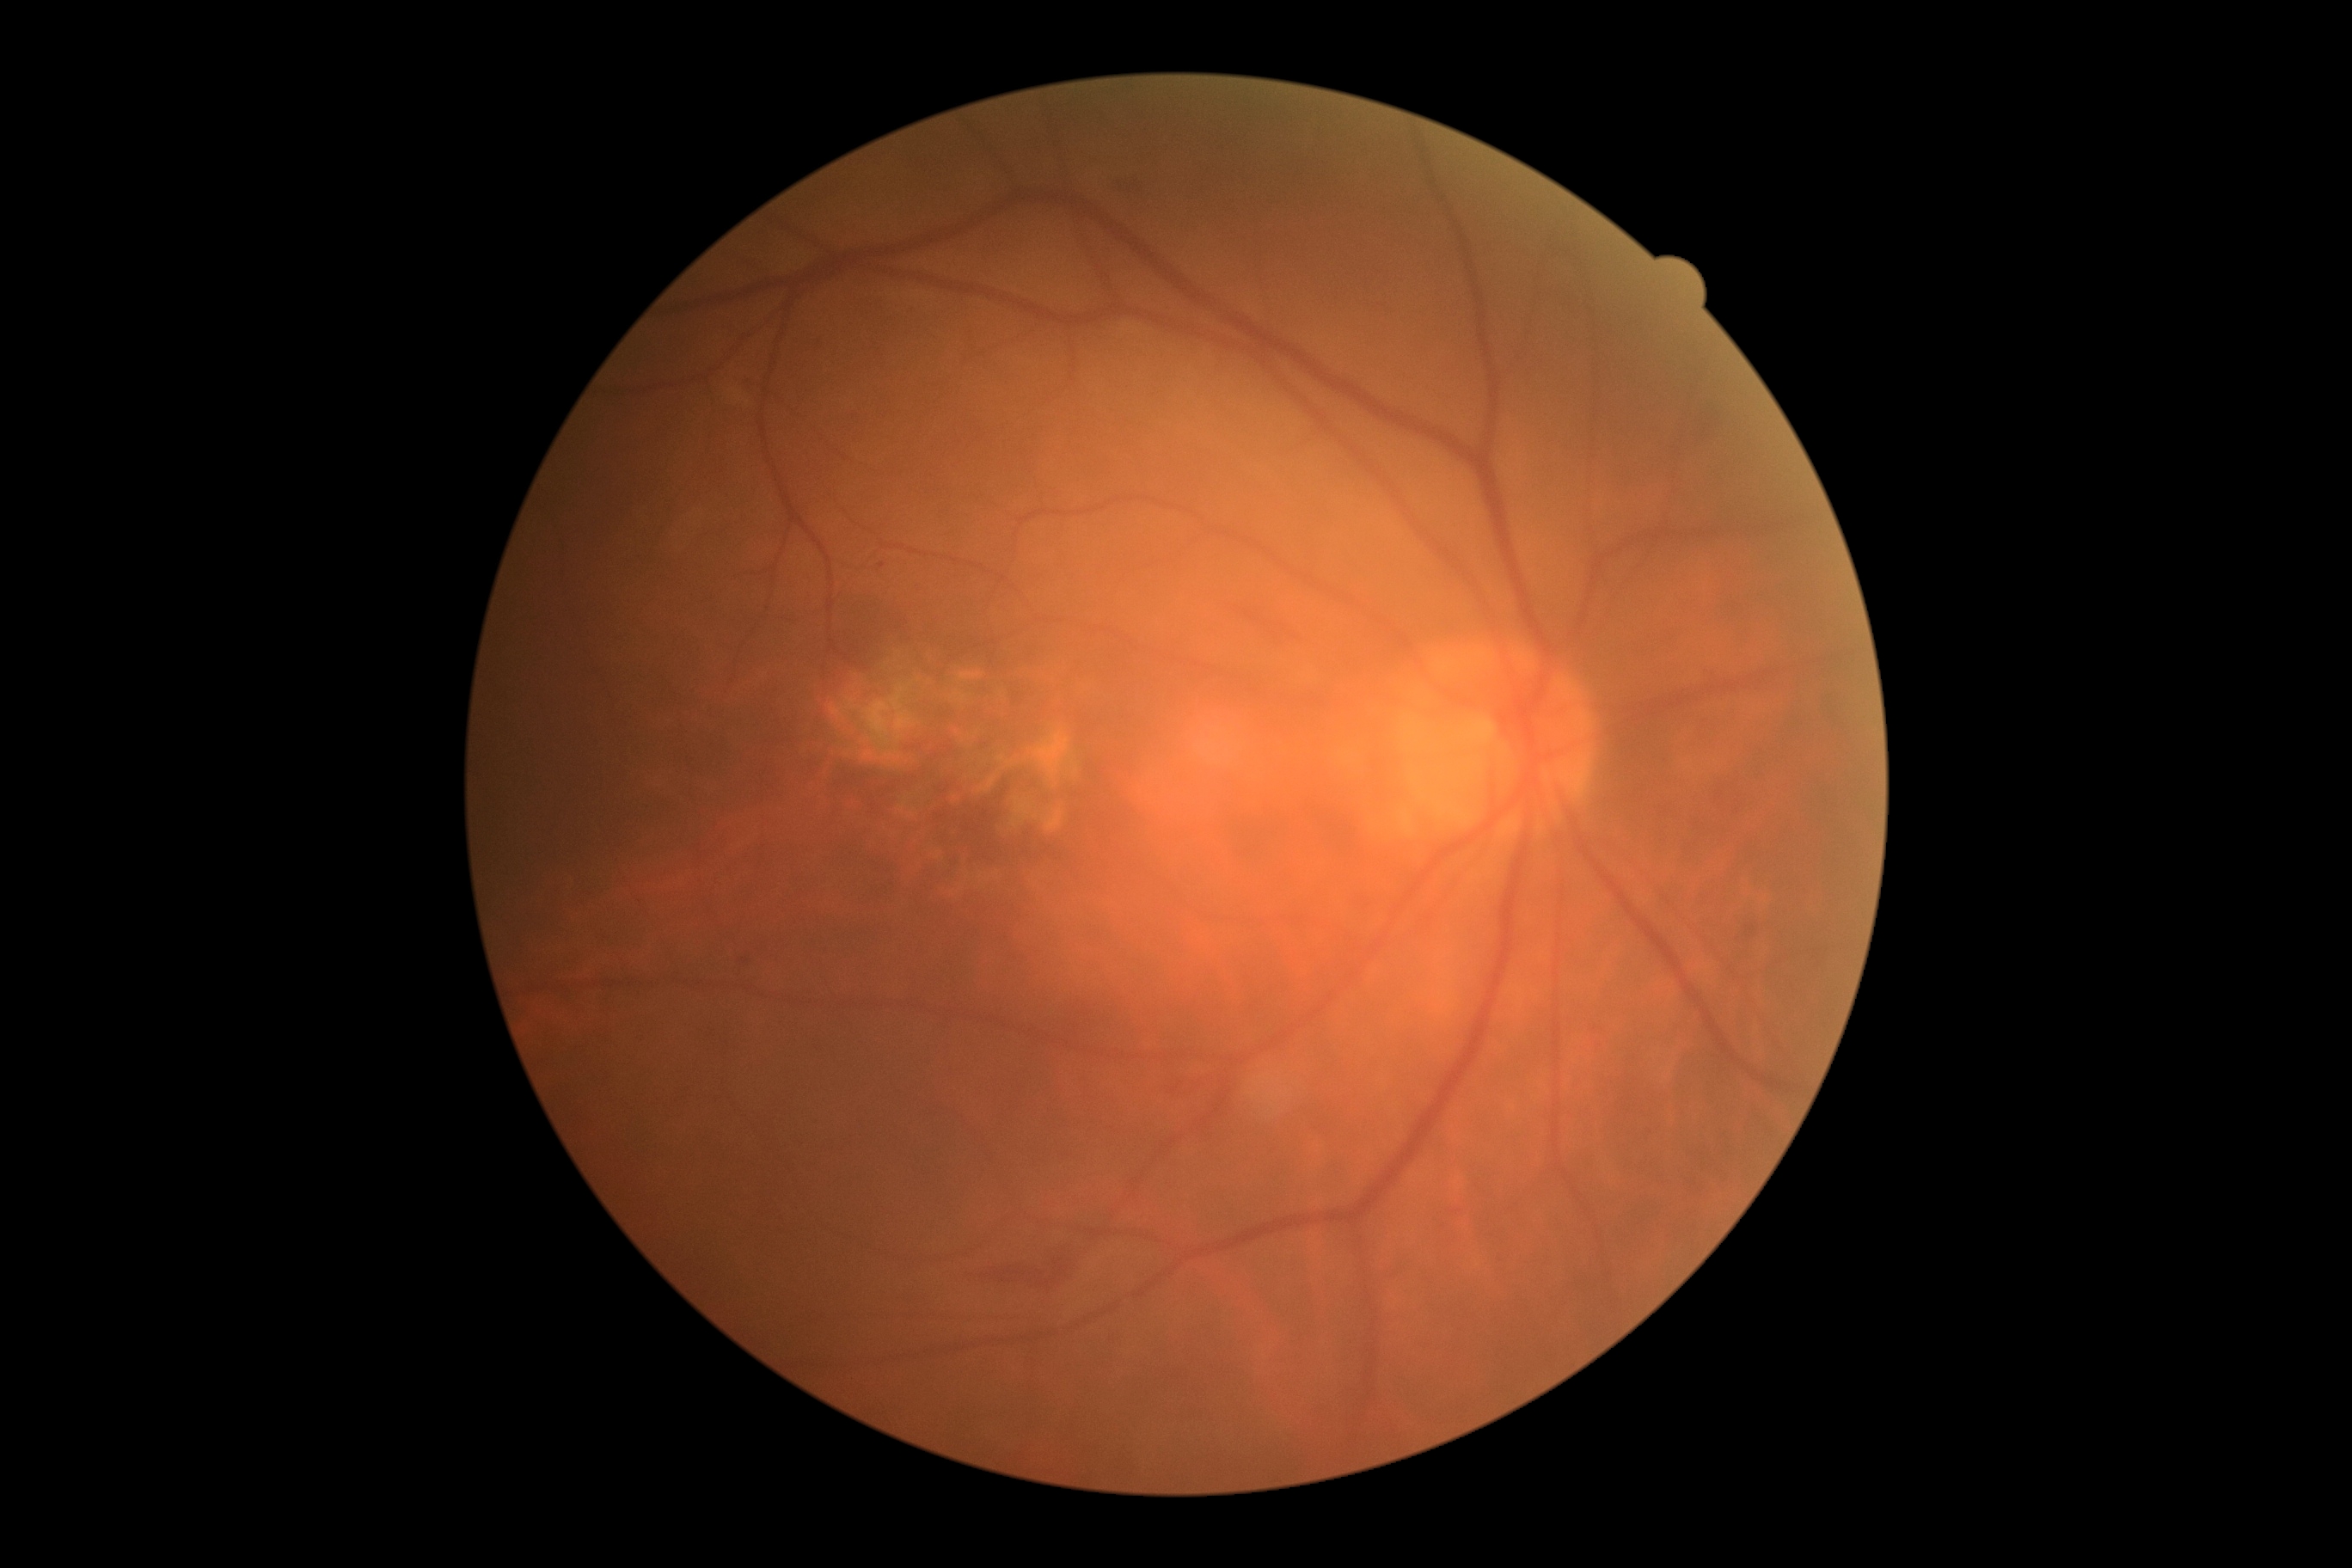 Annotations:
- diabetic retinopathy: moderate non-proliferative diabetic retinopathy (grade 2)